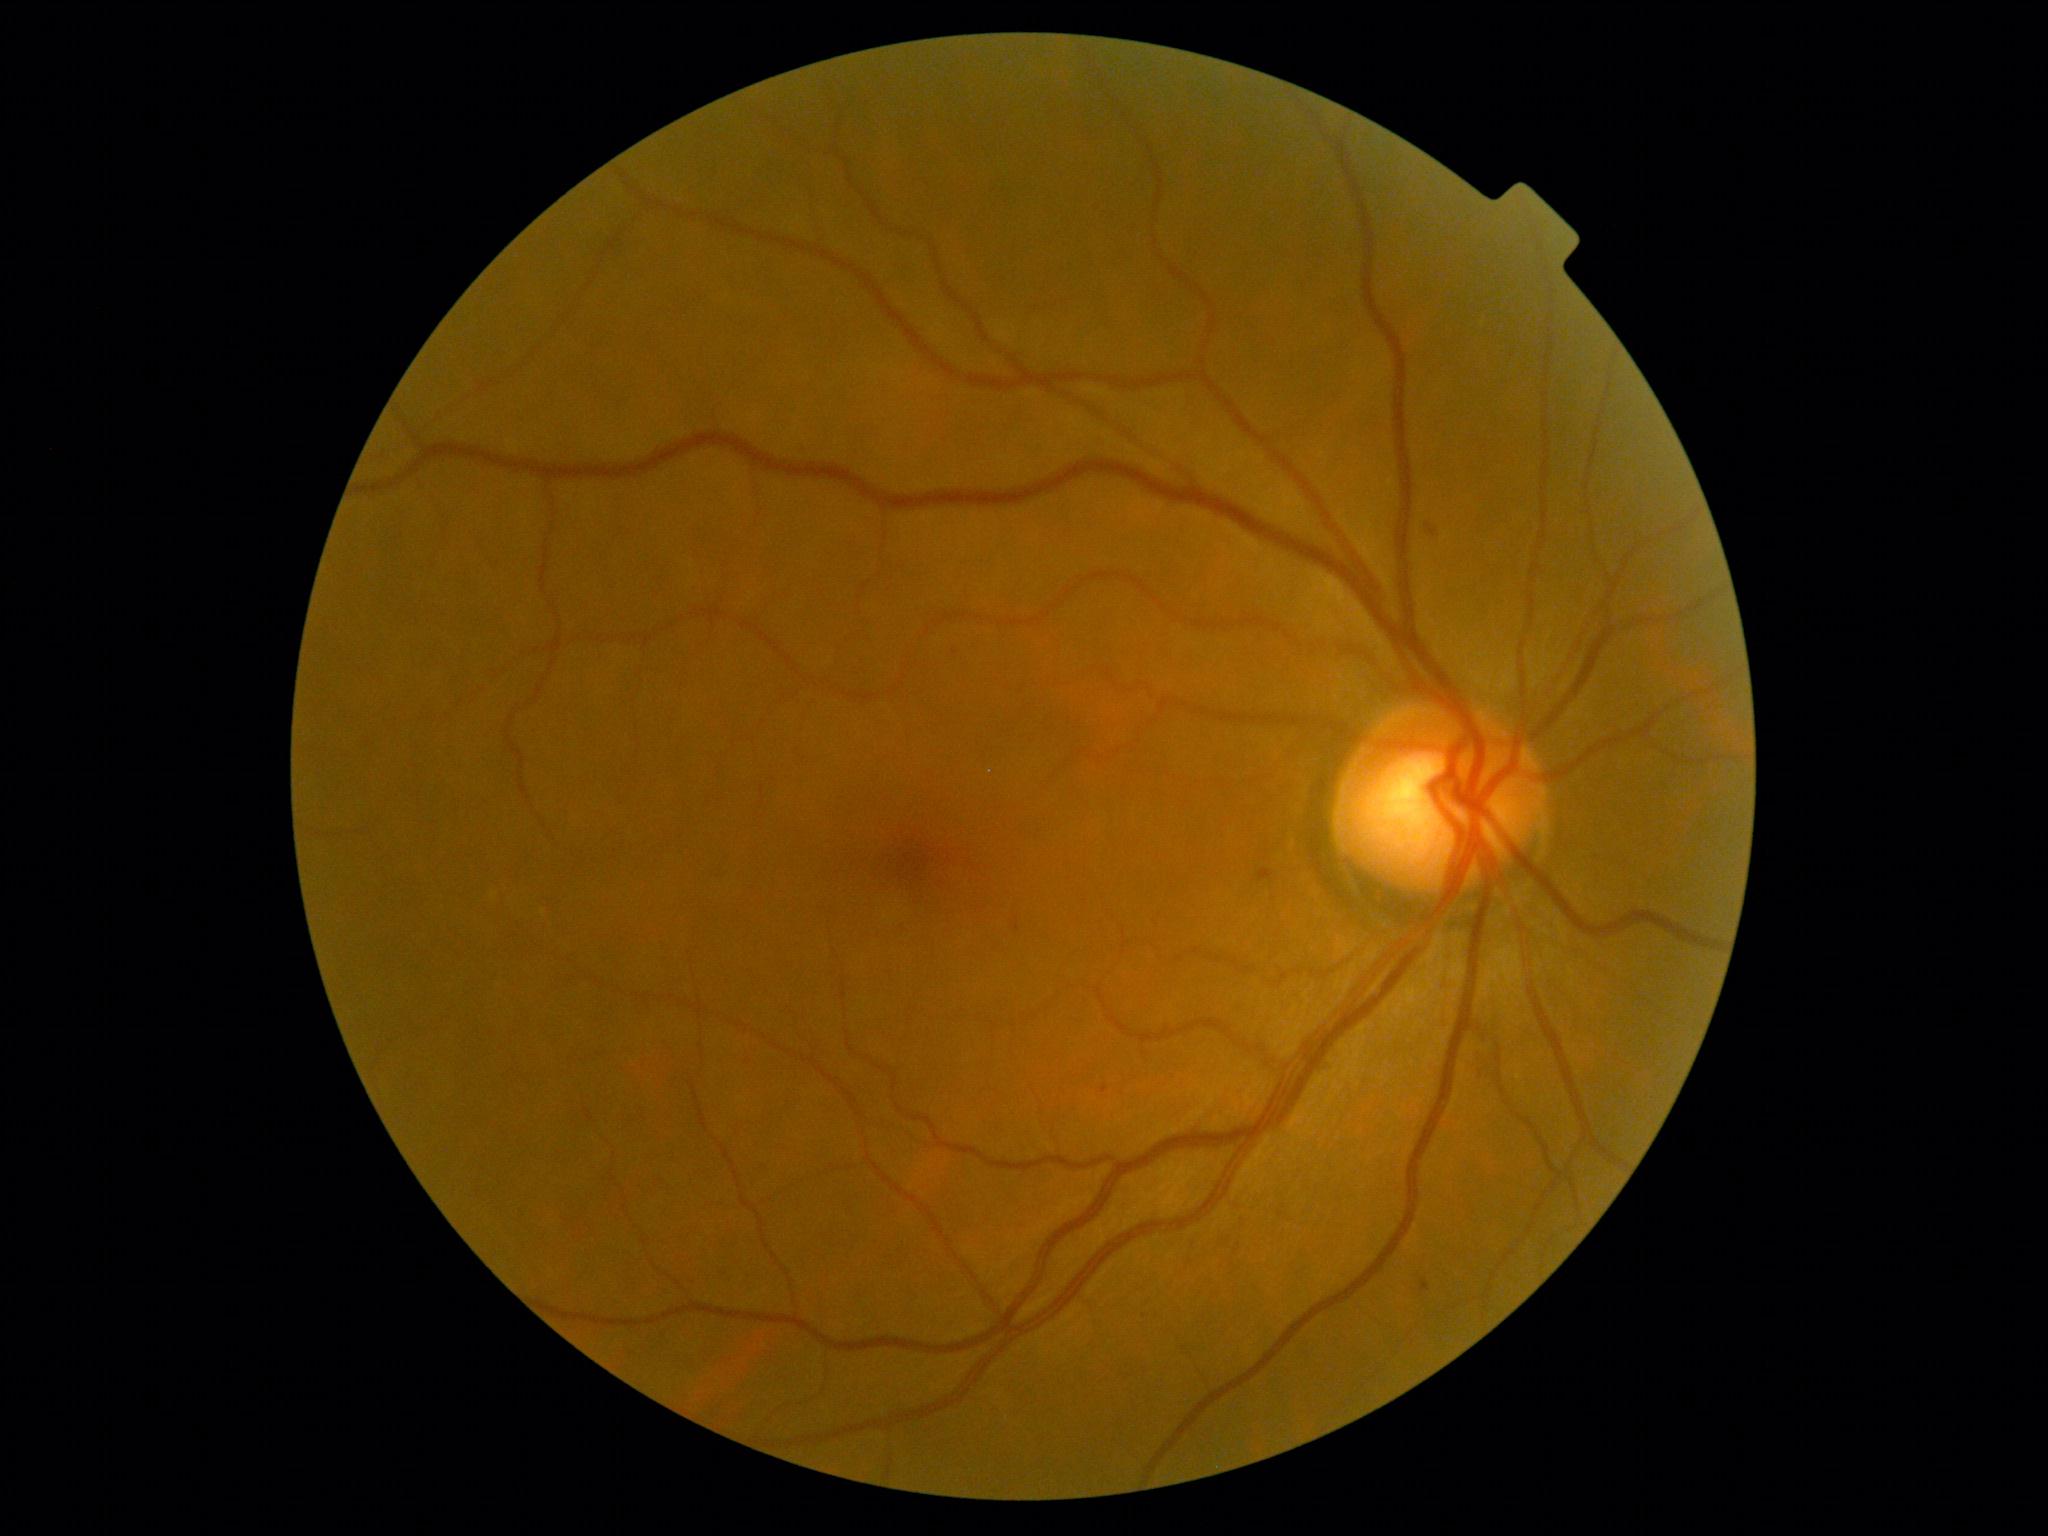
DR class: non-proliferative diabetic retinopathy.
DR: moderate NPDR (grade 2) — more than just microaneurysms but less than severe NPDR.